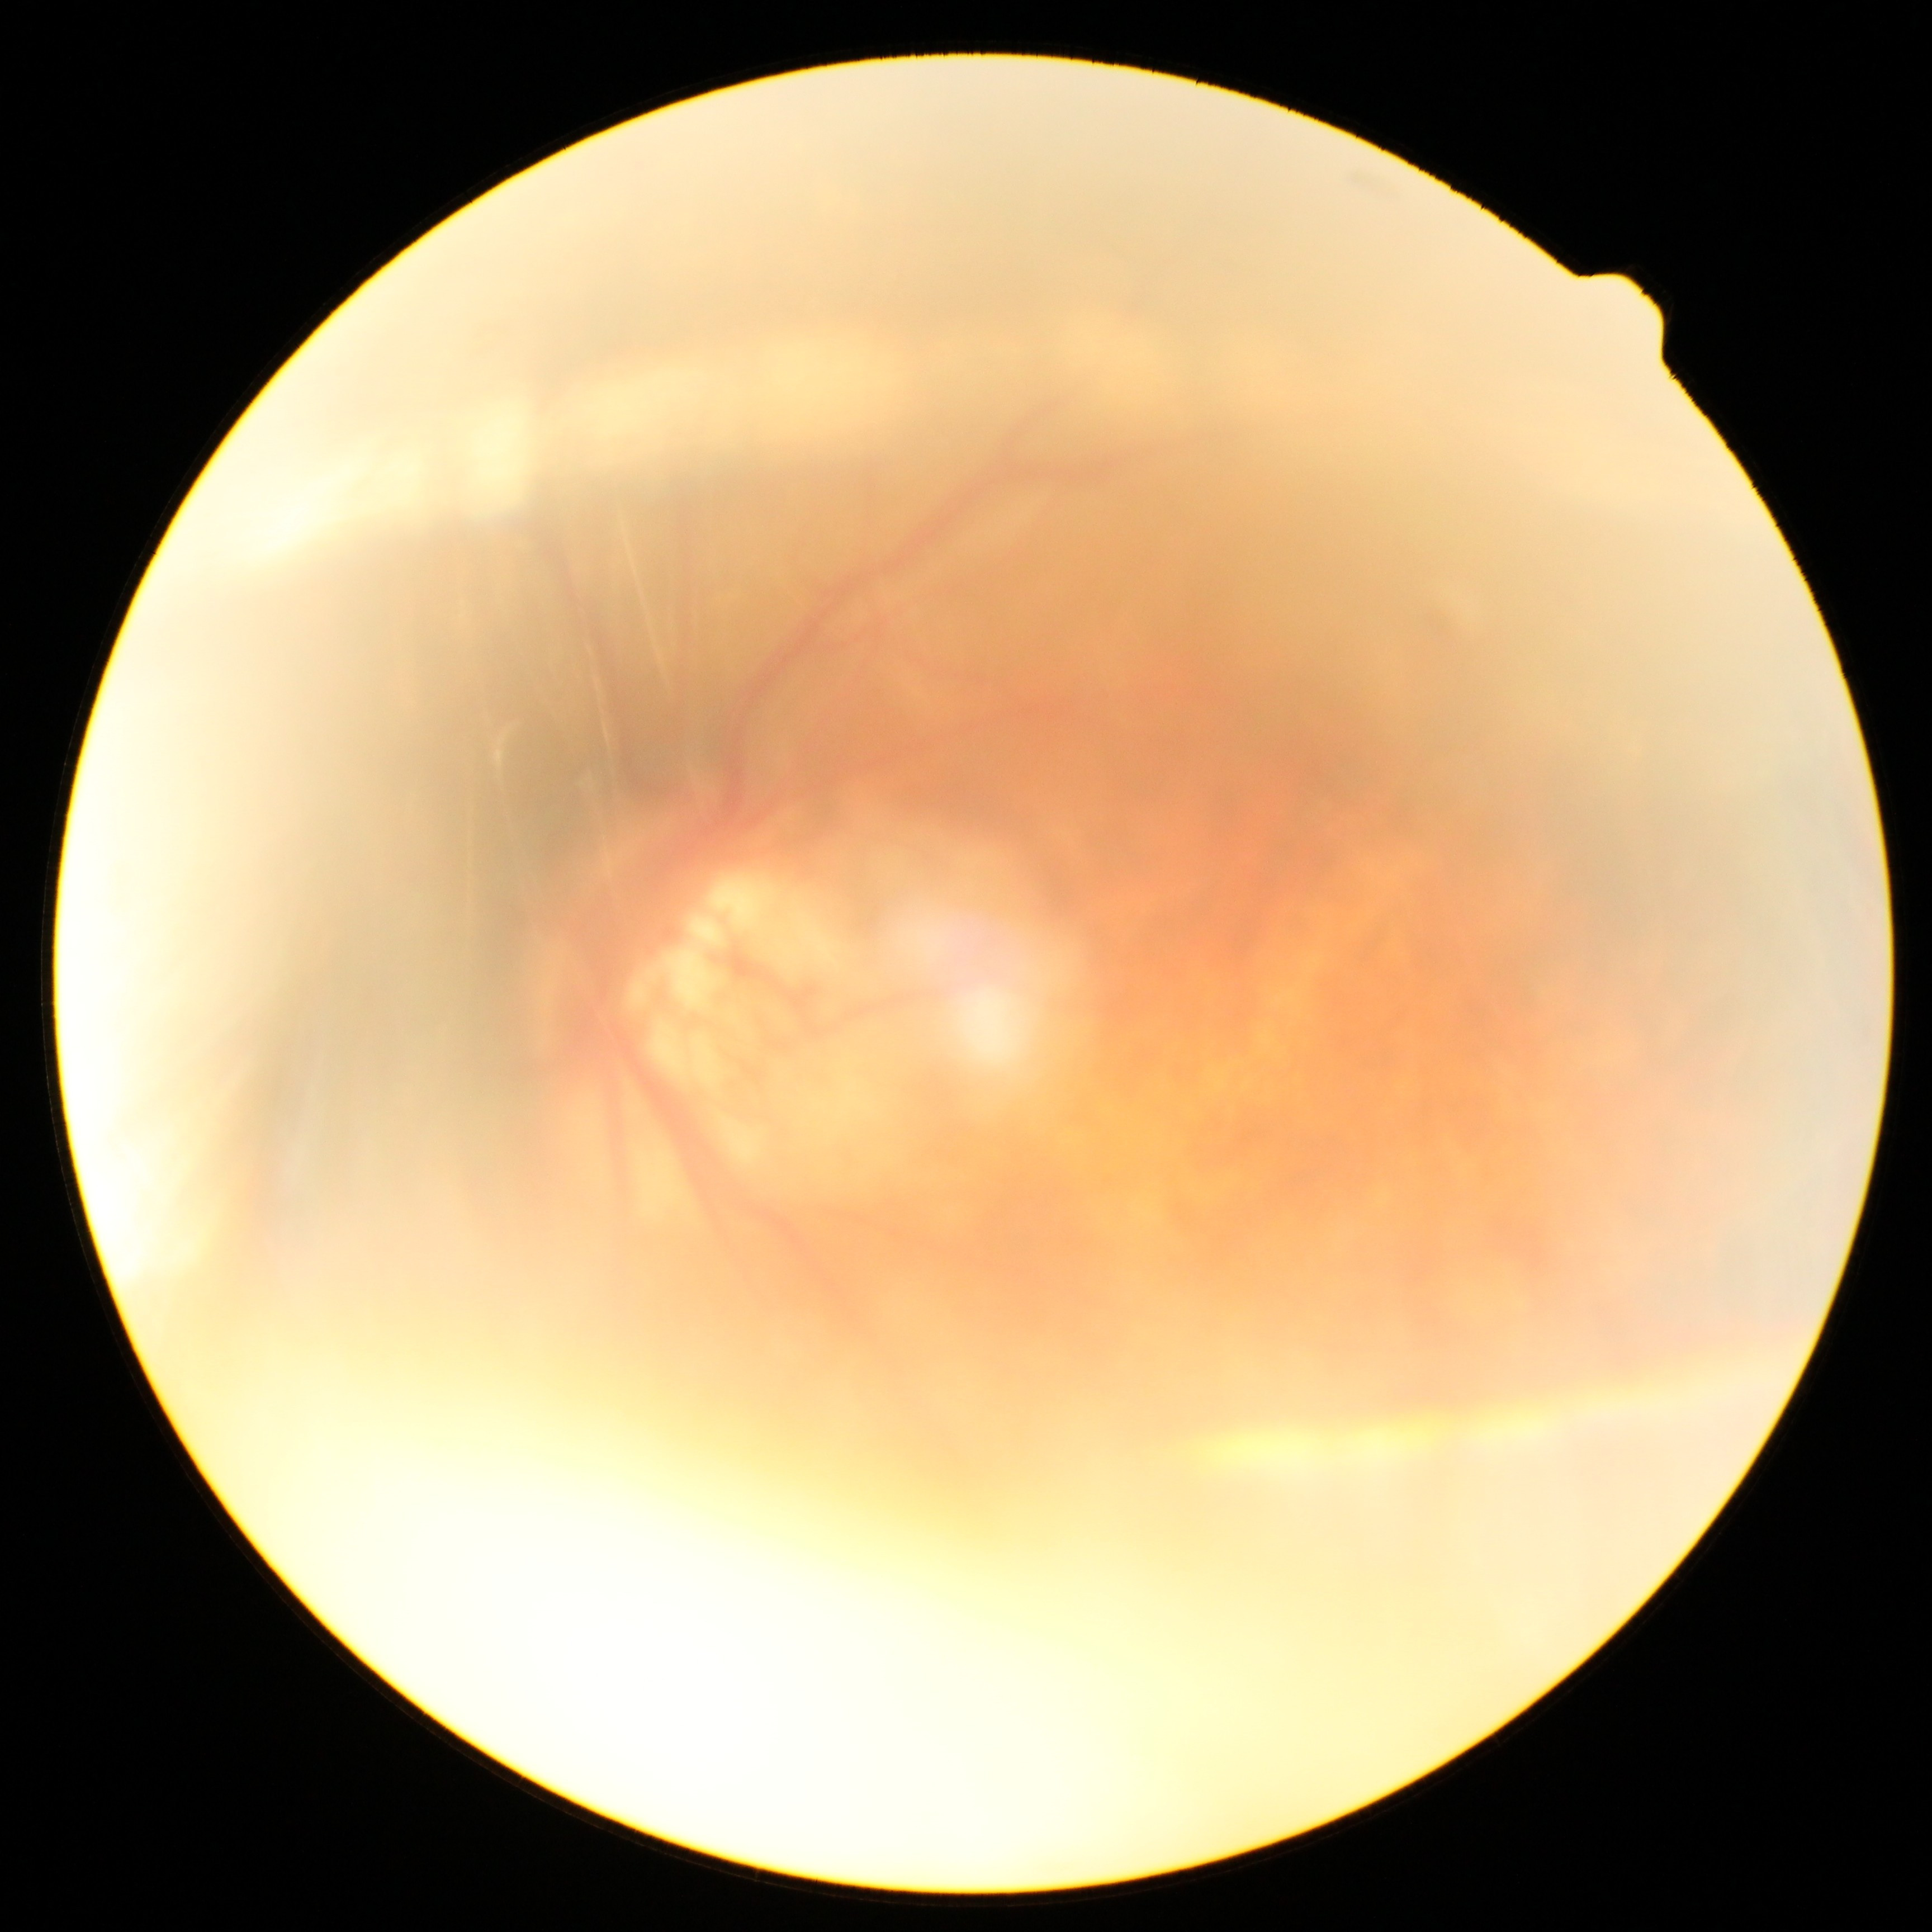
The image cannot be graded for diabetic retinopathy. Diabetic retinopathy (DR) is ungradable.